640x480px. Captured with the Clarity RetCam 3 (130° field of view). Pediatric retinal photograph (wide-field) — 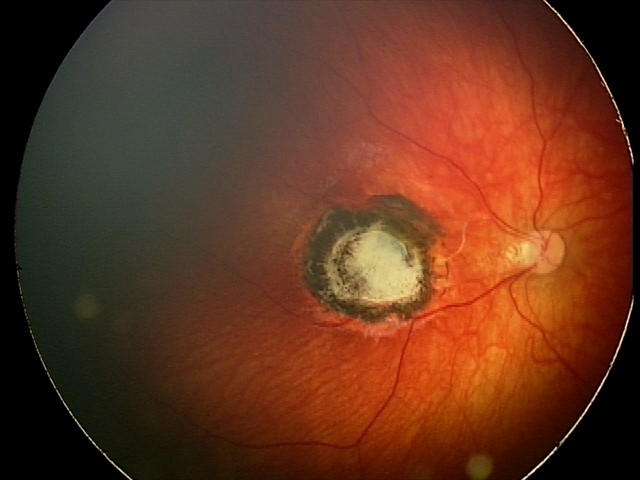
Screening diagnosis: toxoplasmosis chorioretinitis.